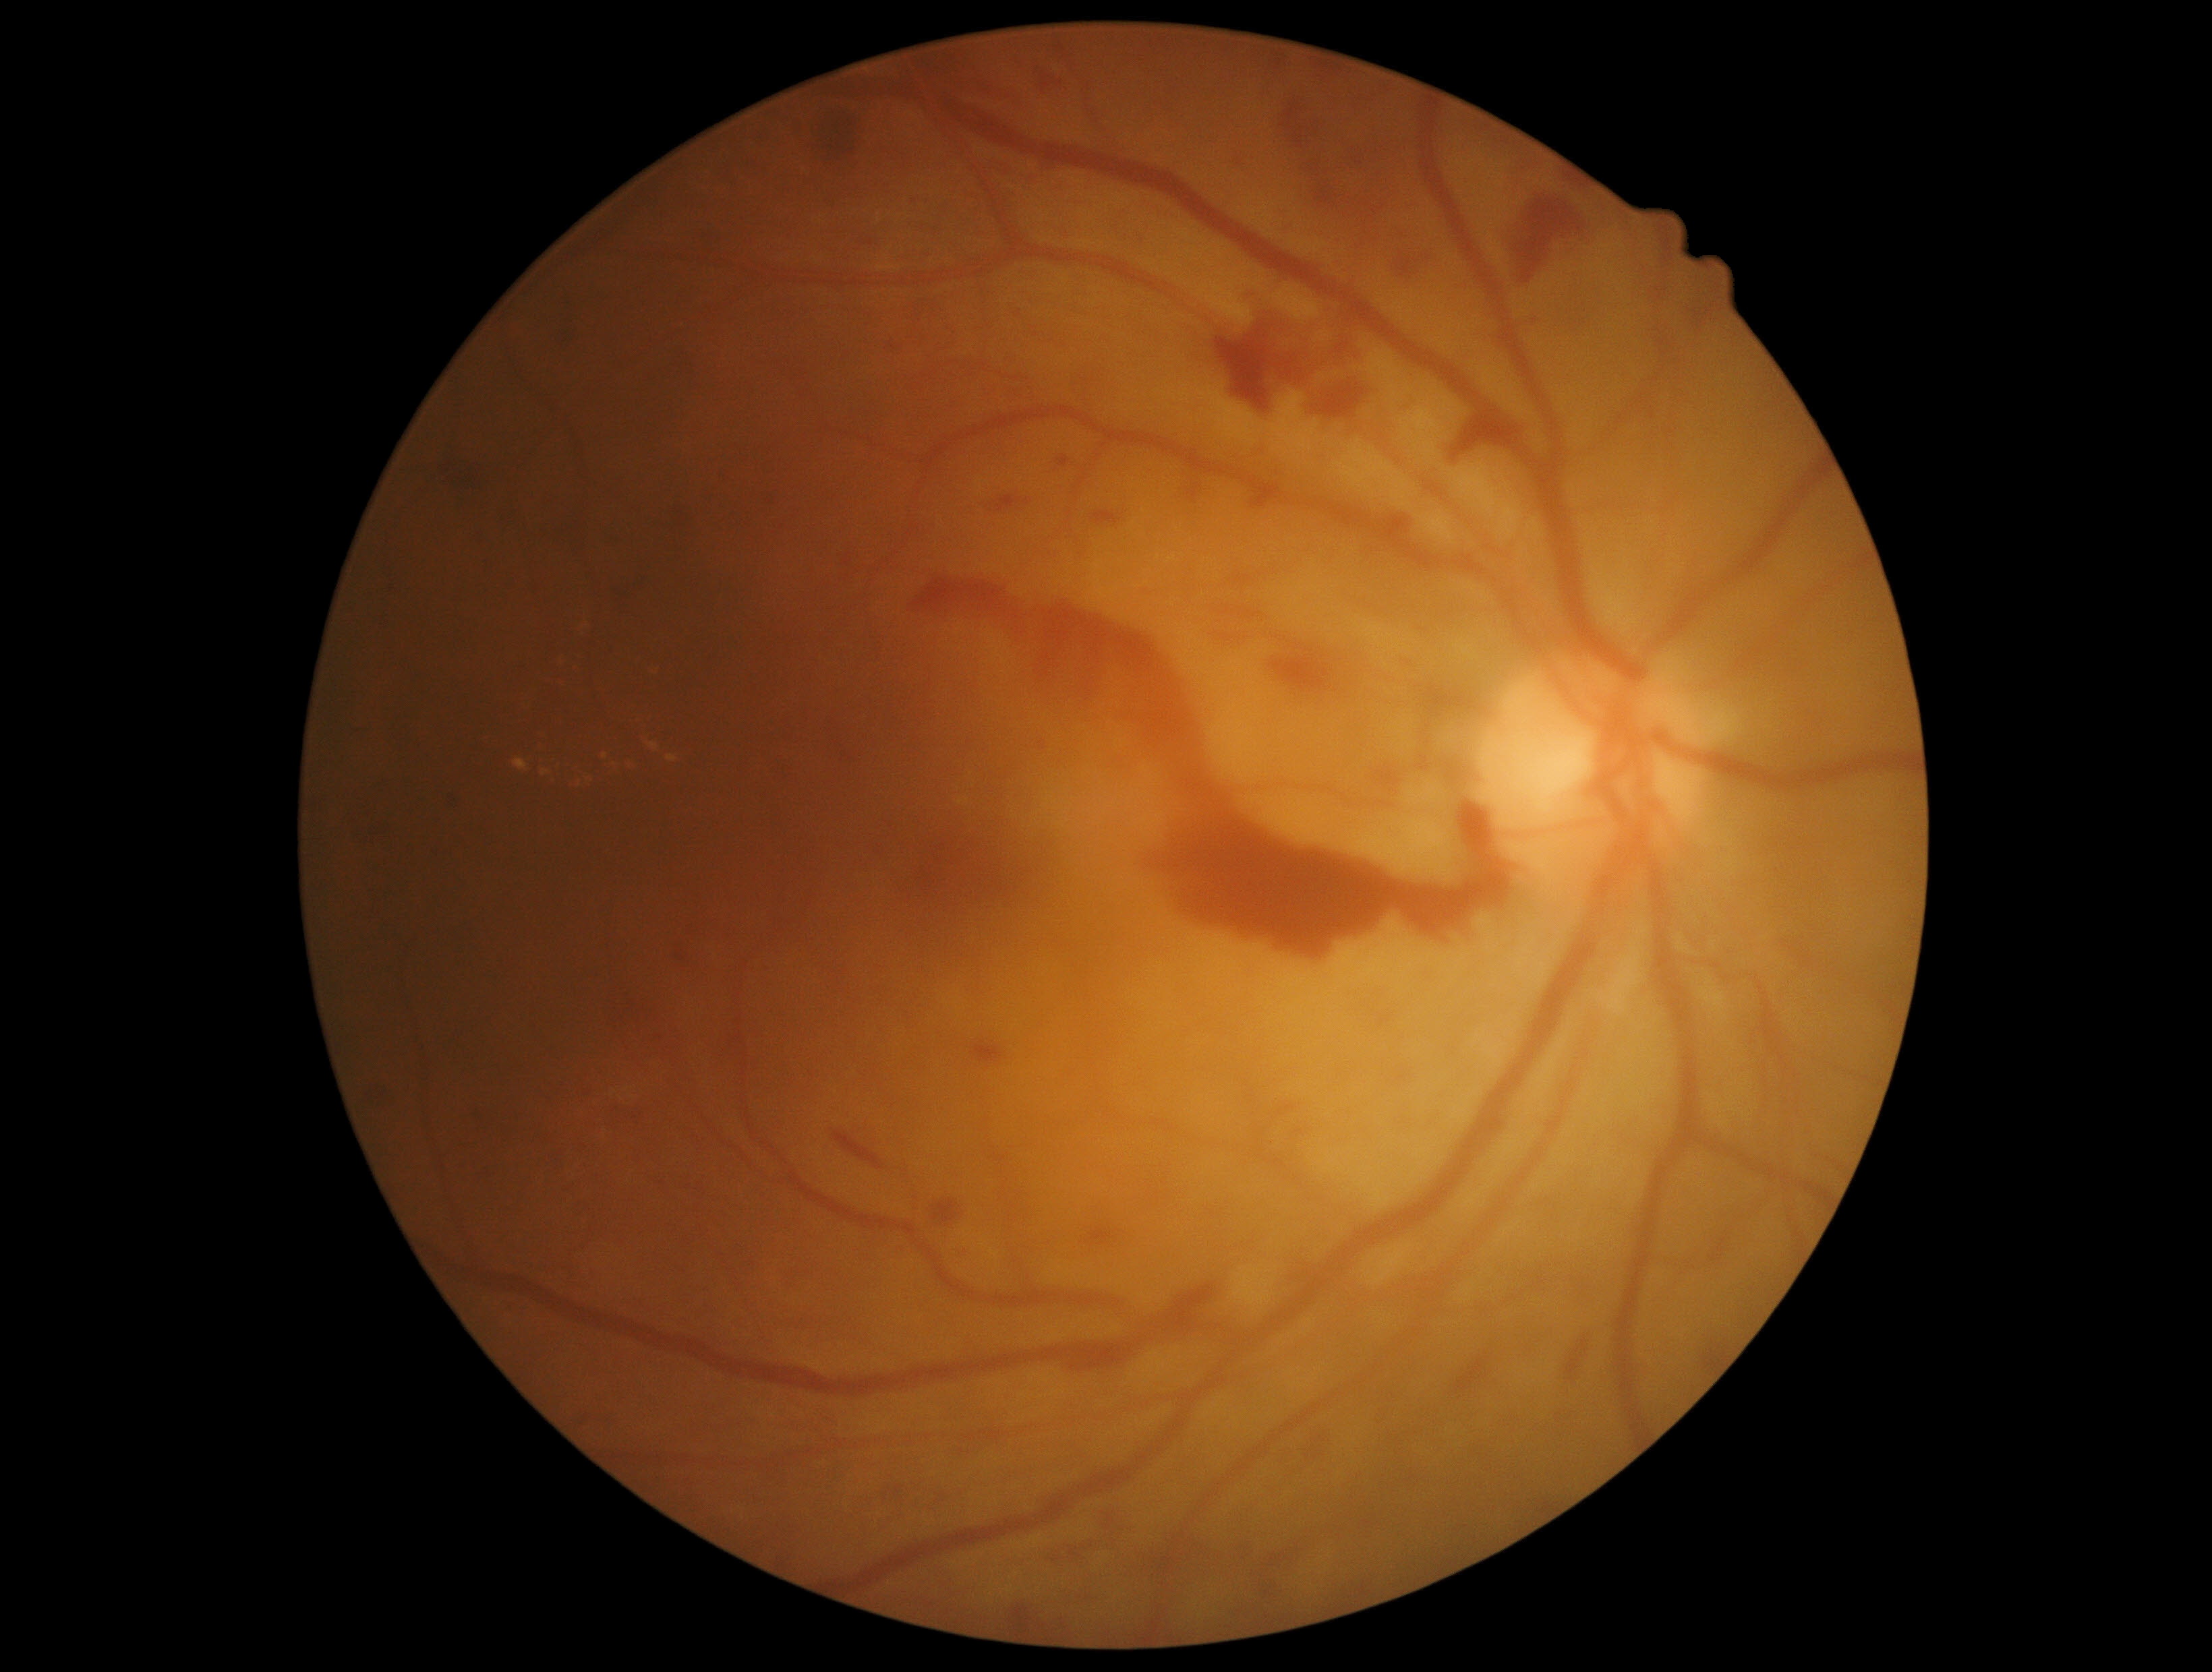
diabetic retinopathy (DR): 4/4 | DR class: proliferative diabetic retinopathy.